1440x1080px.
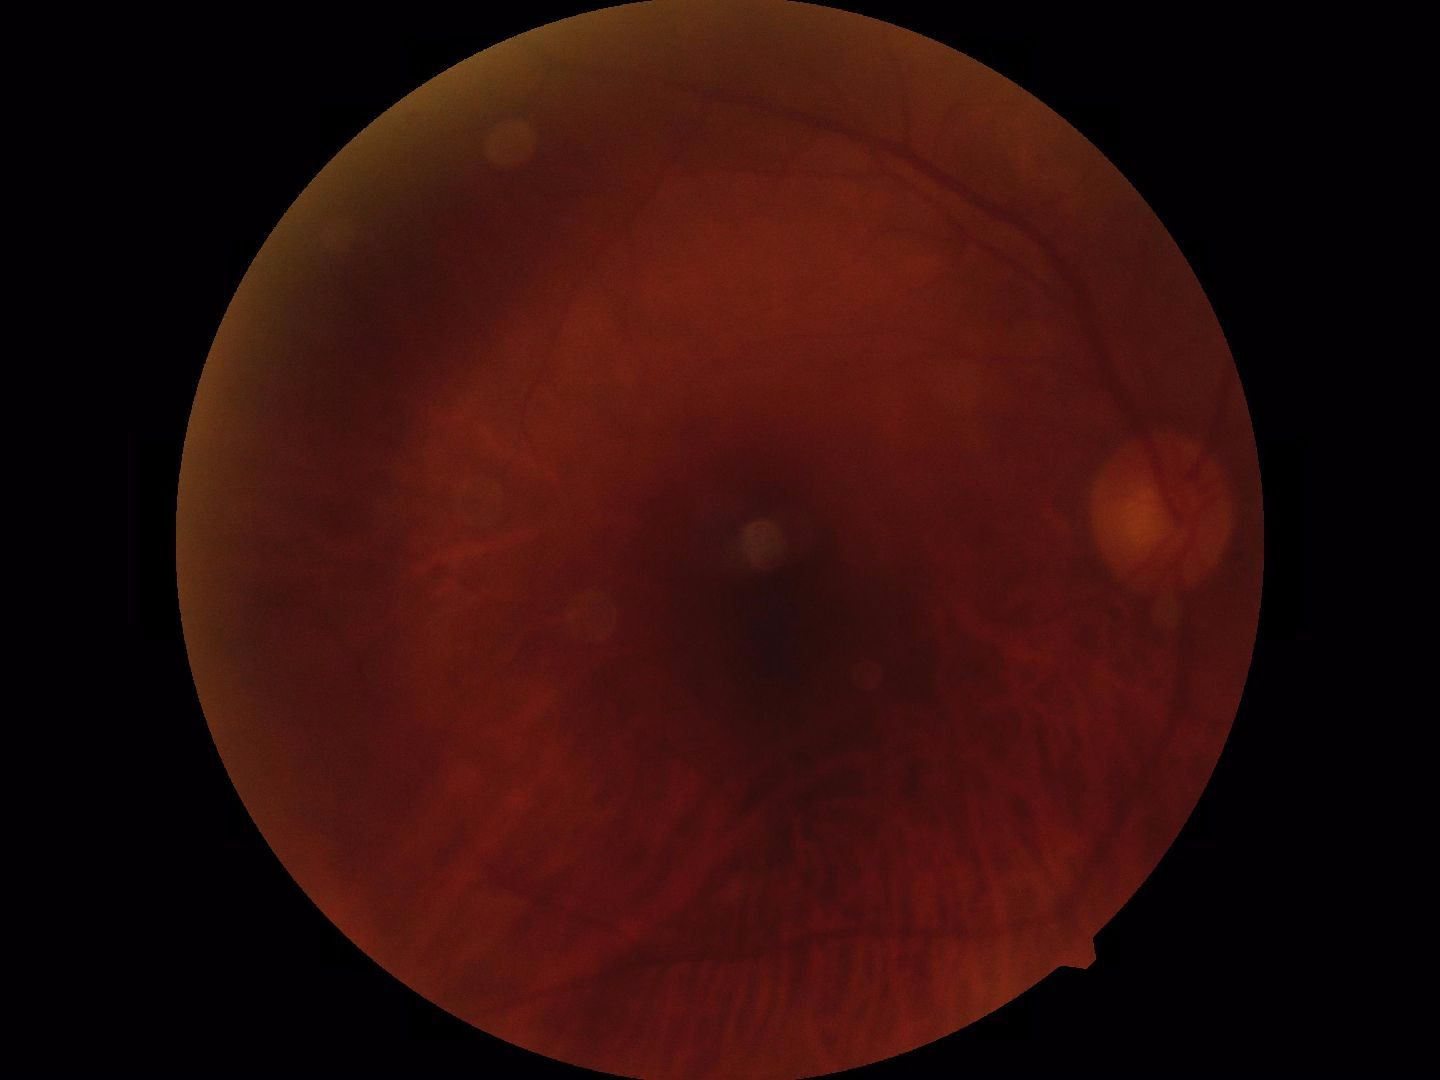
Quality: poor.
Proliferative retinopathy: negative.